45° field of view; 2048x1536: 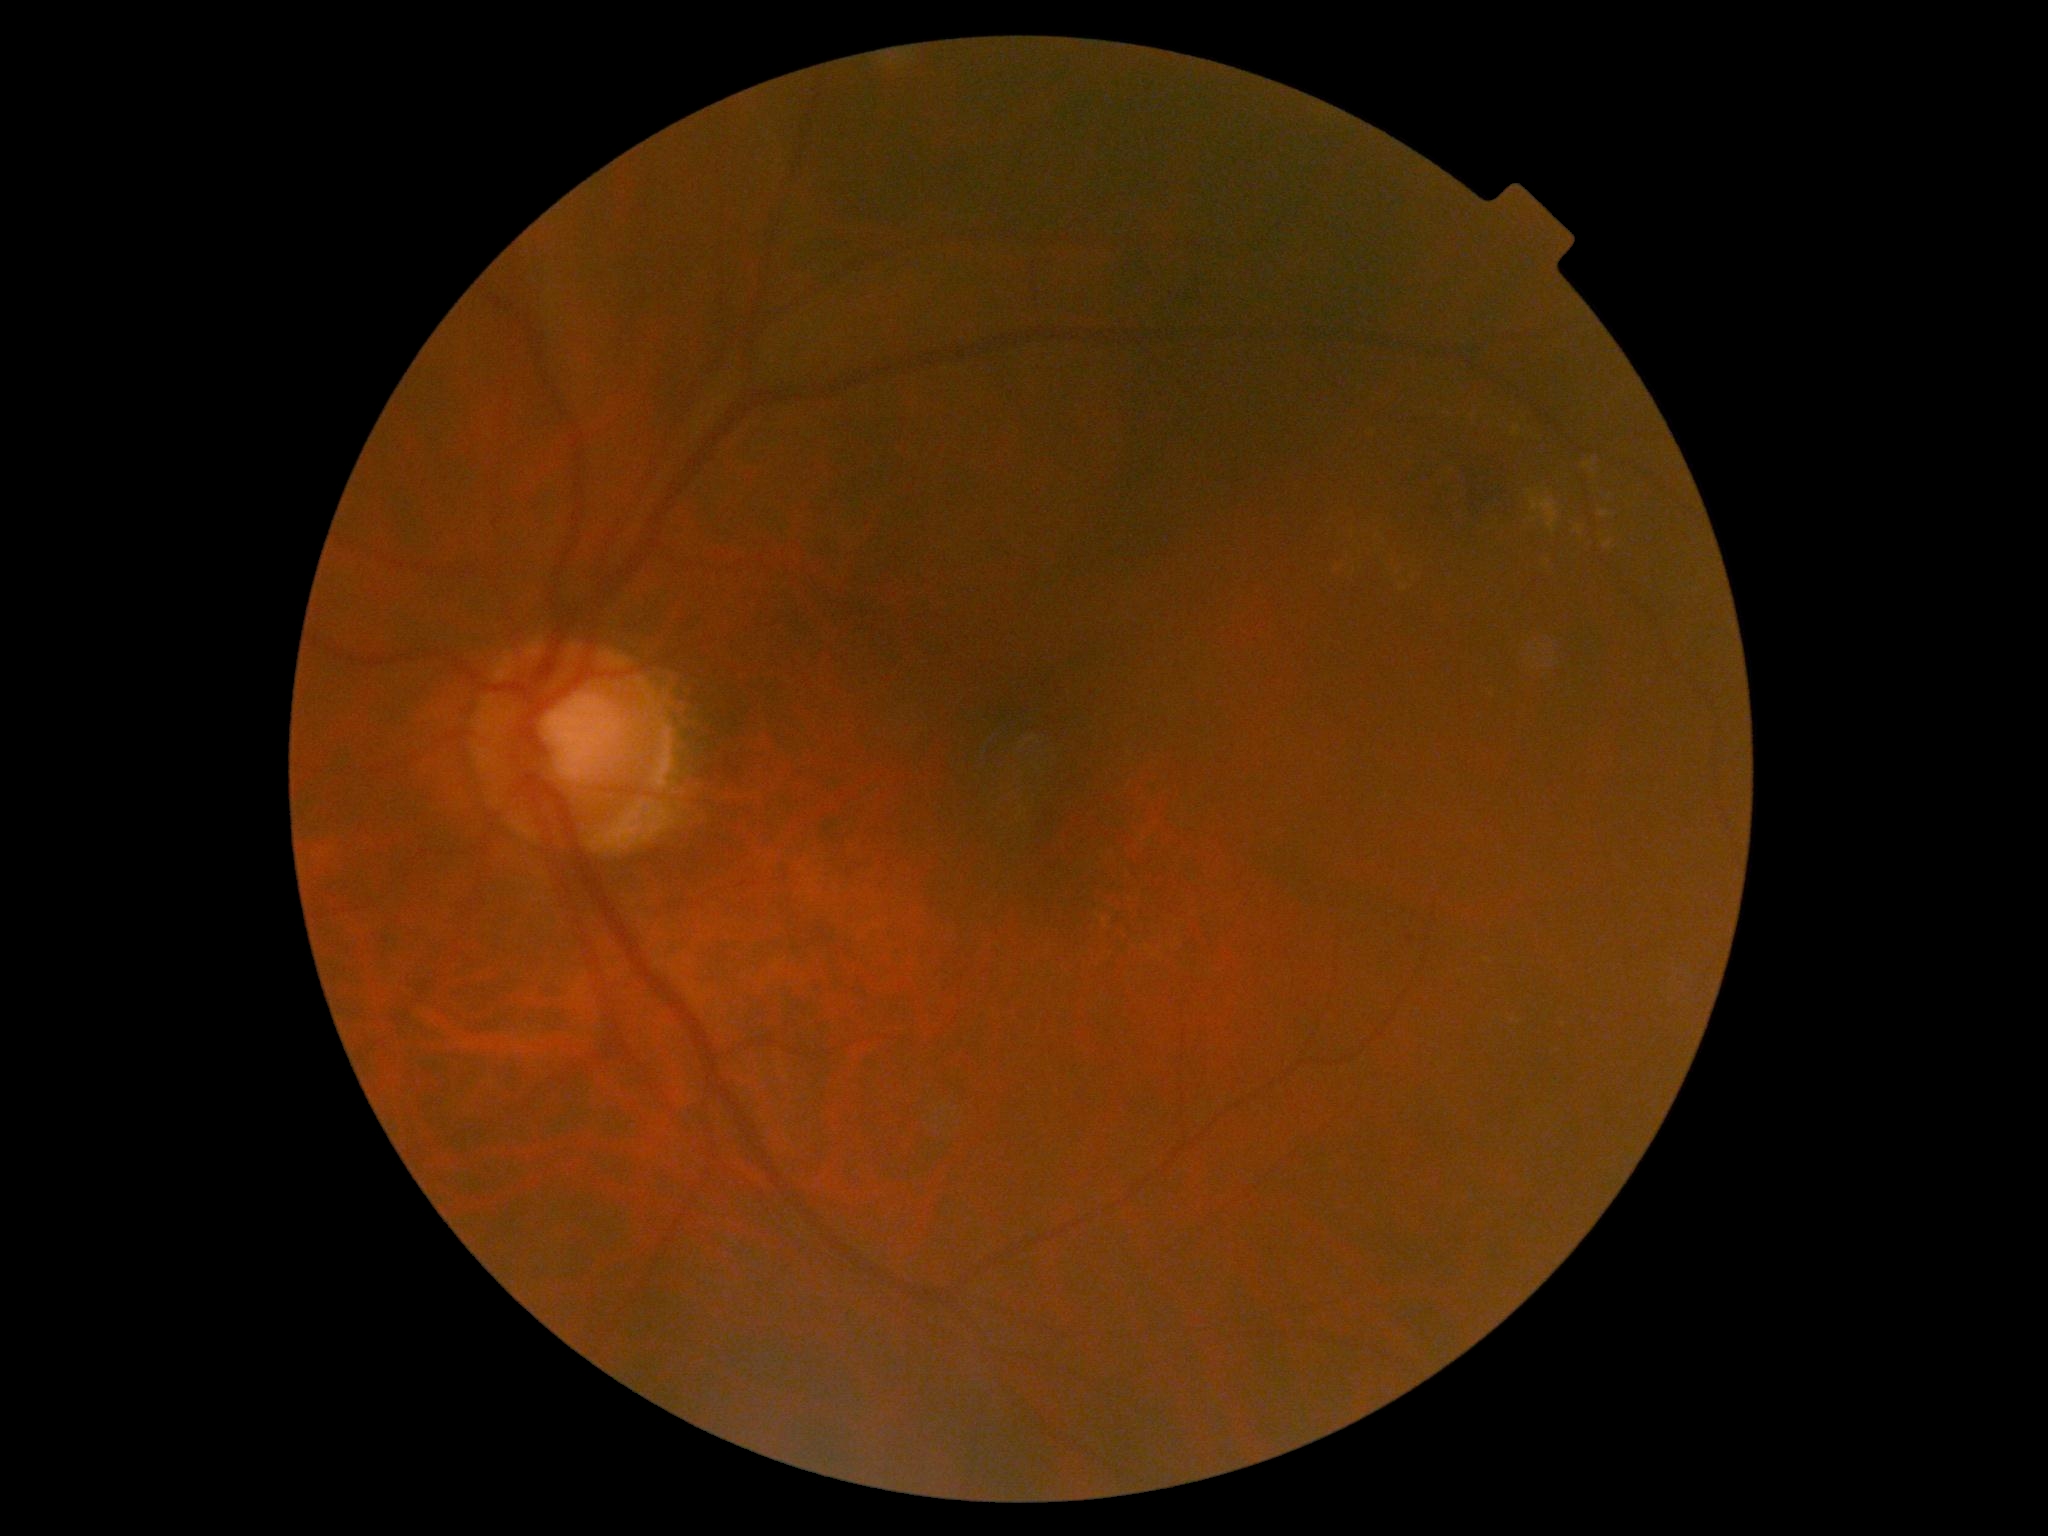 DR grade@moderate non-proliferative diabetic retinopathy (2), DR class@non-proliferative diabetic retinopathy.